2352 by 1568 pixels; CFP:
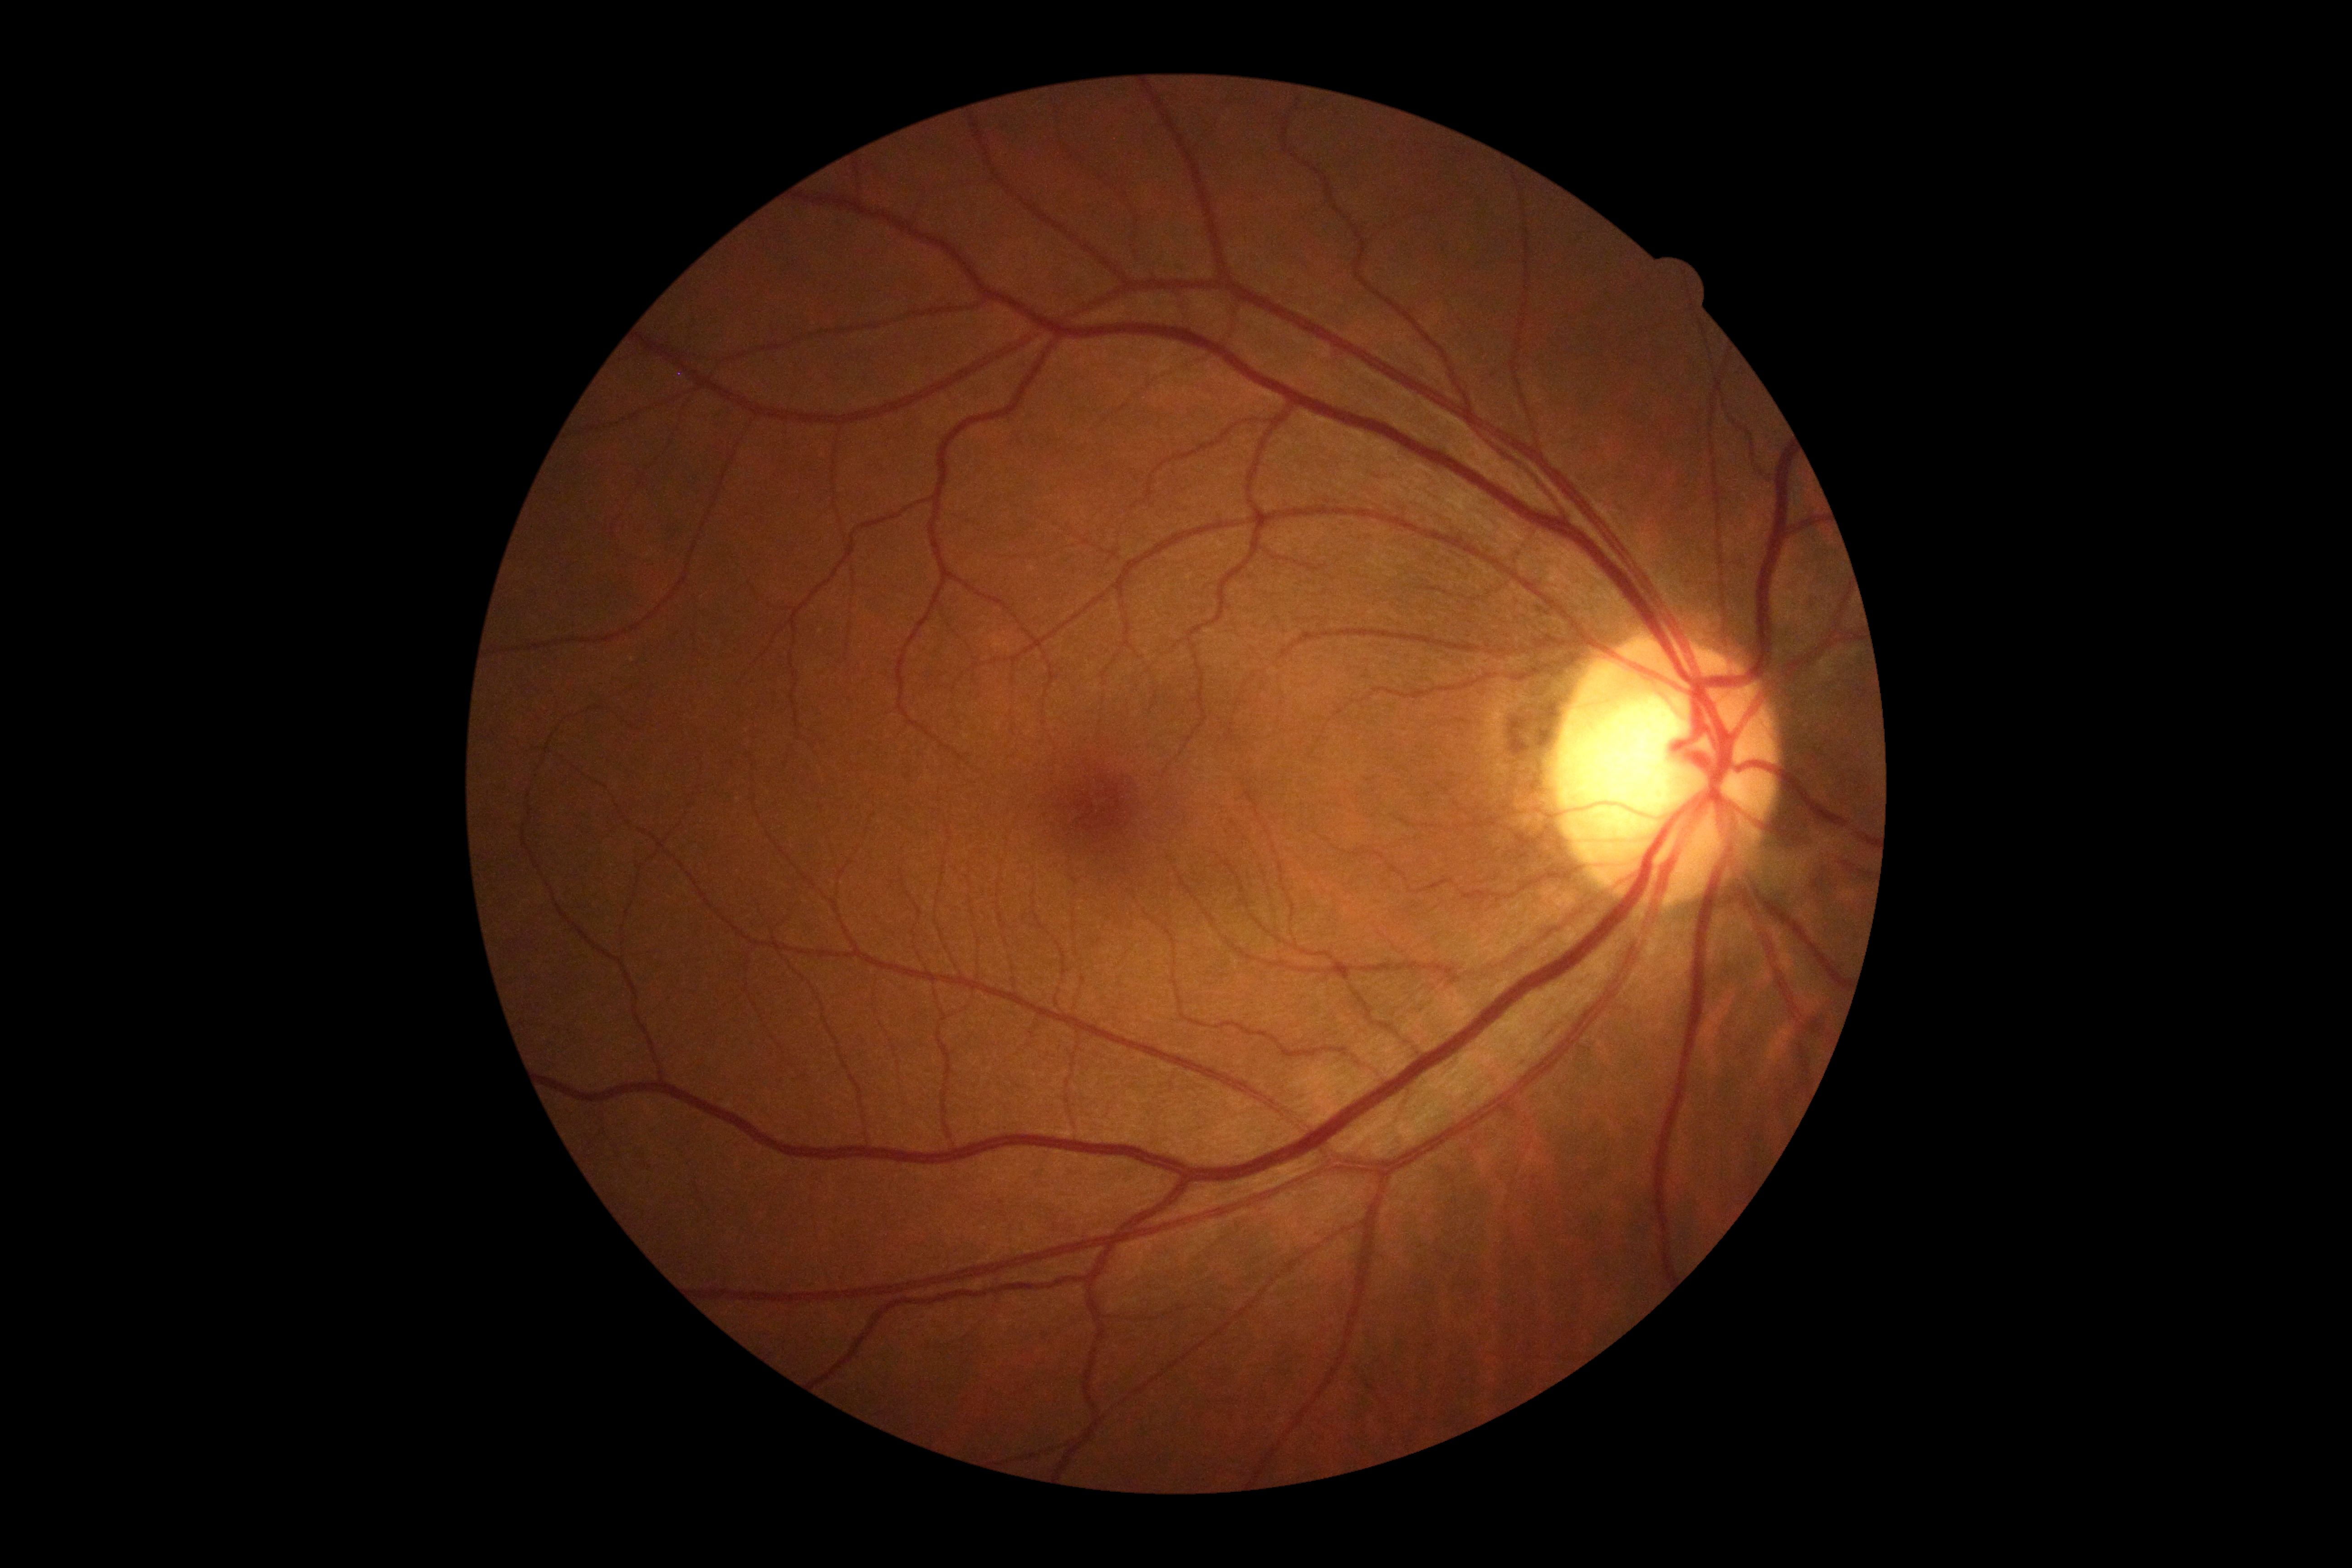 No diabetic retinal disease findings.
Diabetic retinopathy (DR): grade 0.